Infant wide-field retinal image · acquired on the Clarity RetCam 3 — 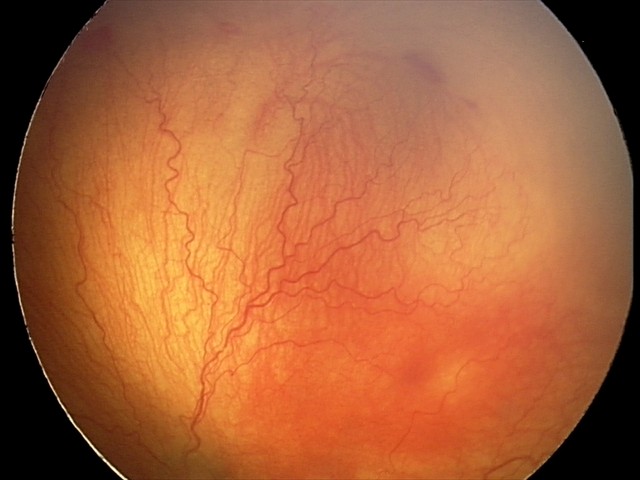 Screening diagnosis: aggressive retinopathy of prematurity (A-ROP) — rapidly progressive severe ROP with prominent plus disease, often without classic stage progression | plus disease — abnormal dilation and tortuosity of the posterior pole retinal vessels.